Wide-field contact fundus photograph of an infant · Phoenix ICON, 100° FOV
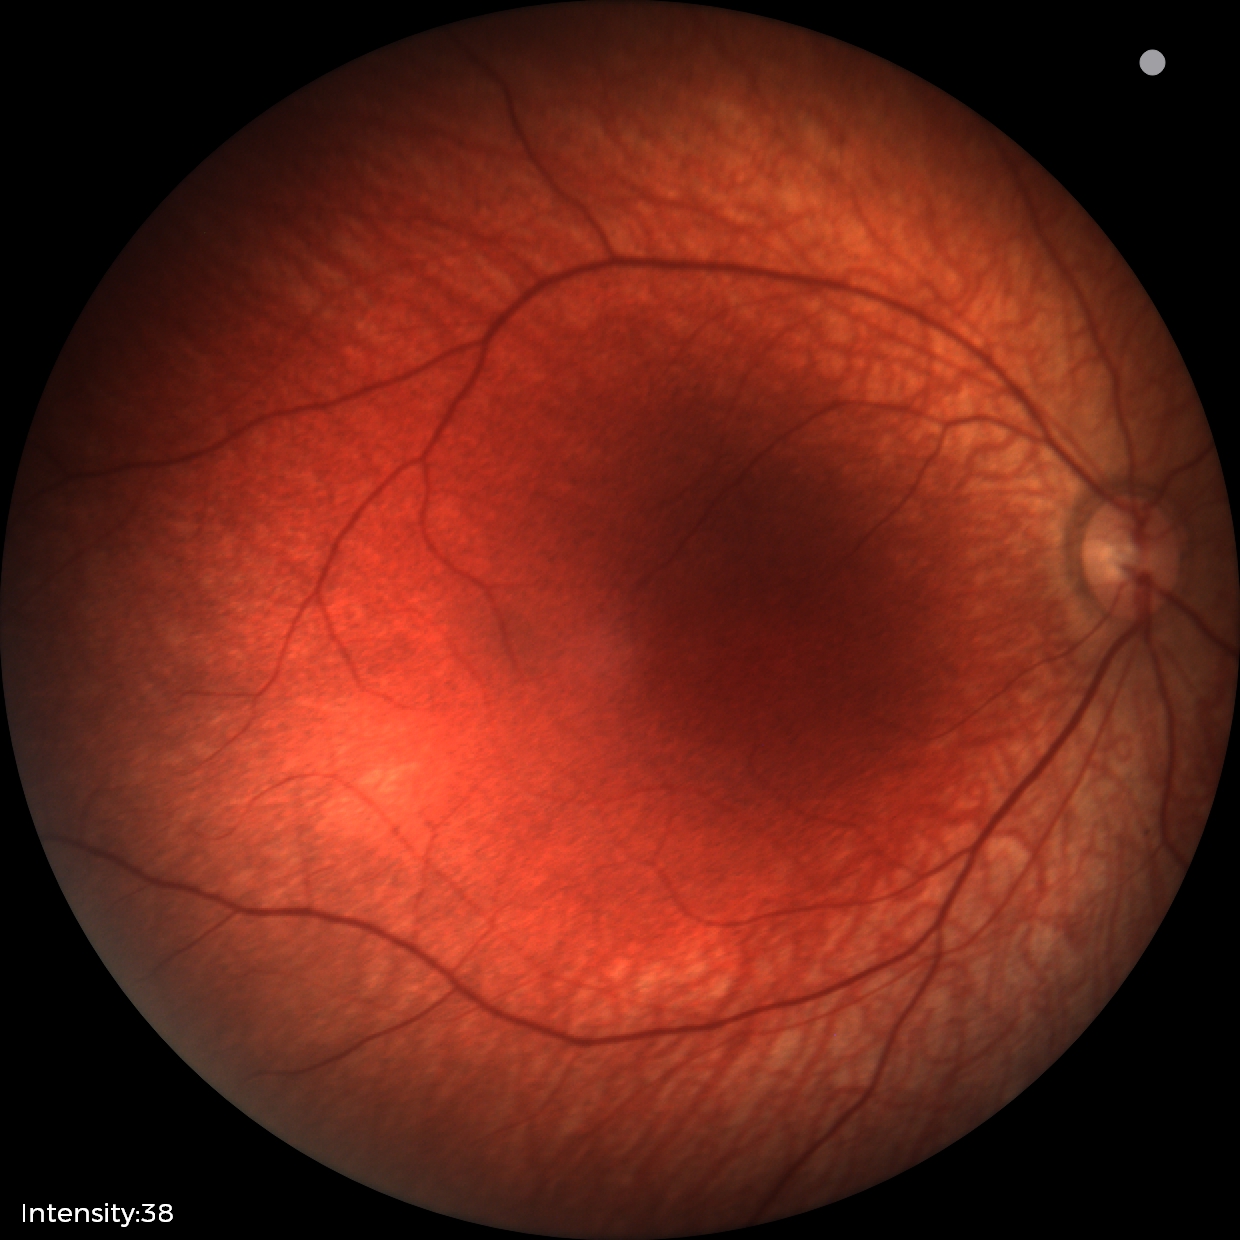 Normal screening examination.